Graded on the modified Davis scale: 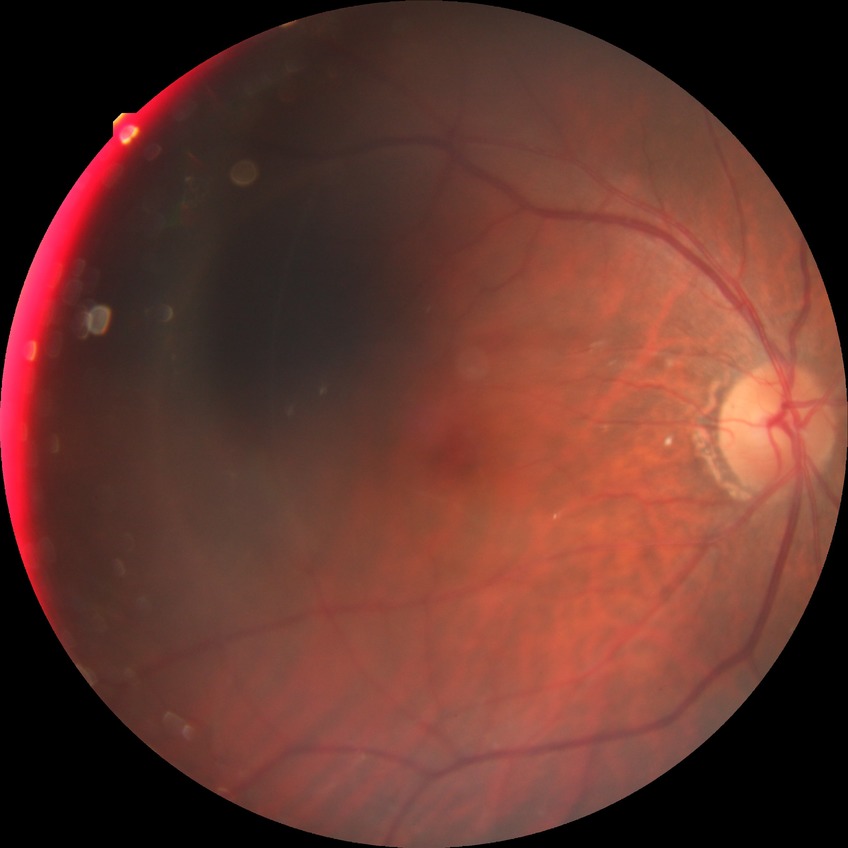
Findings:
* diabetic retinopathy (DR): no diabetic retinopathy (NDR)